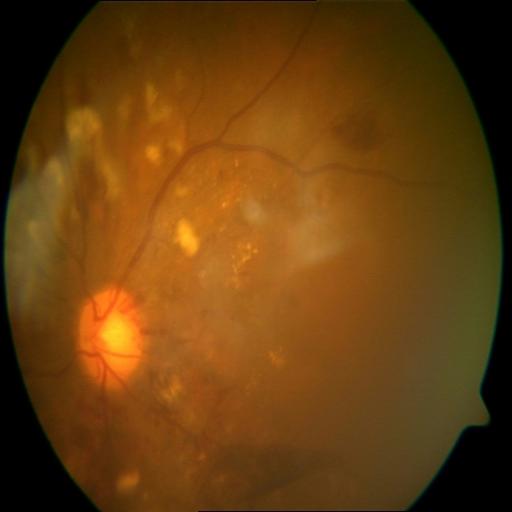

Retinal fundus photograph demonstrating cystoid macular edema, hemorrhagic retinopathy, and cotton wool spots.